2212x1659px: 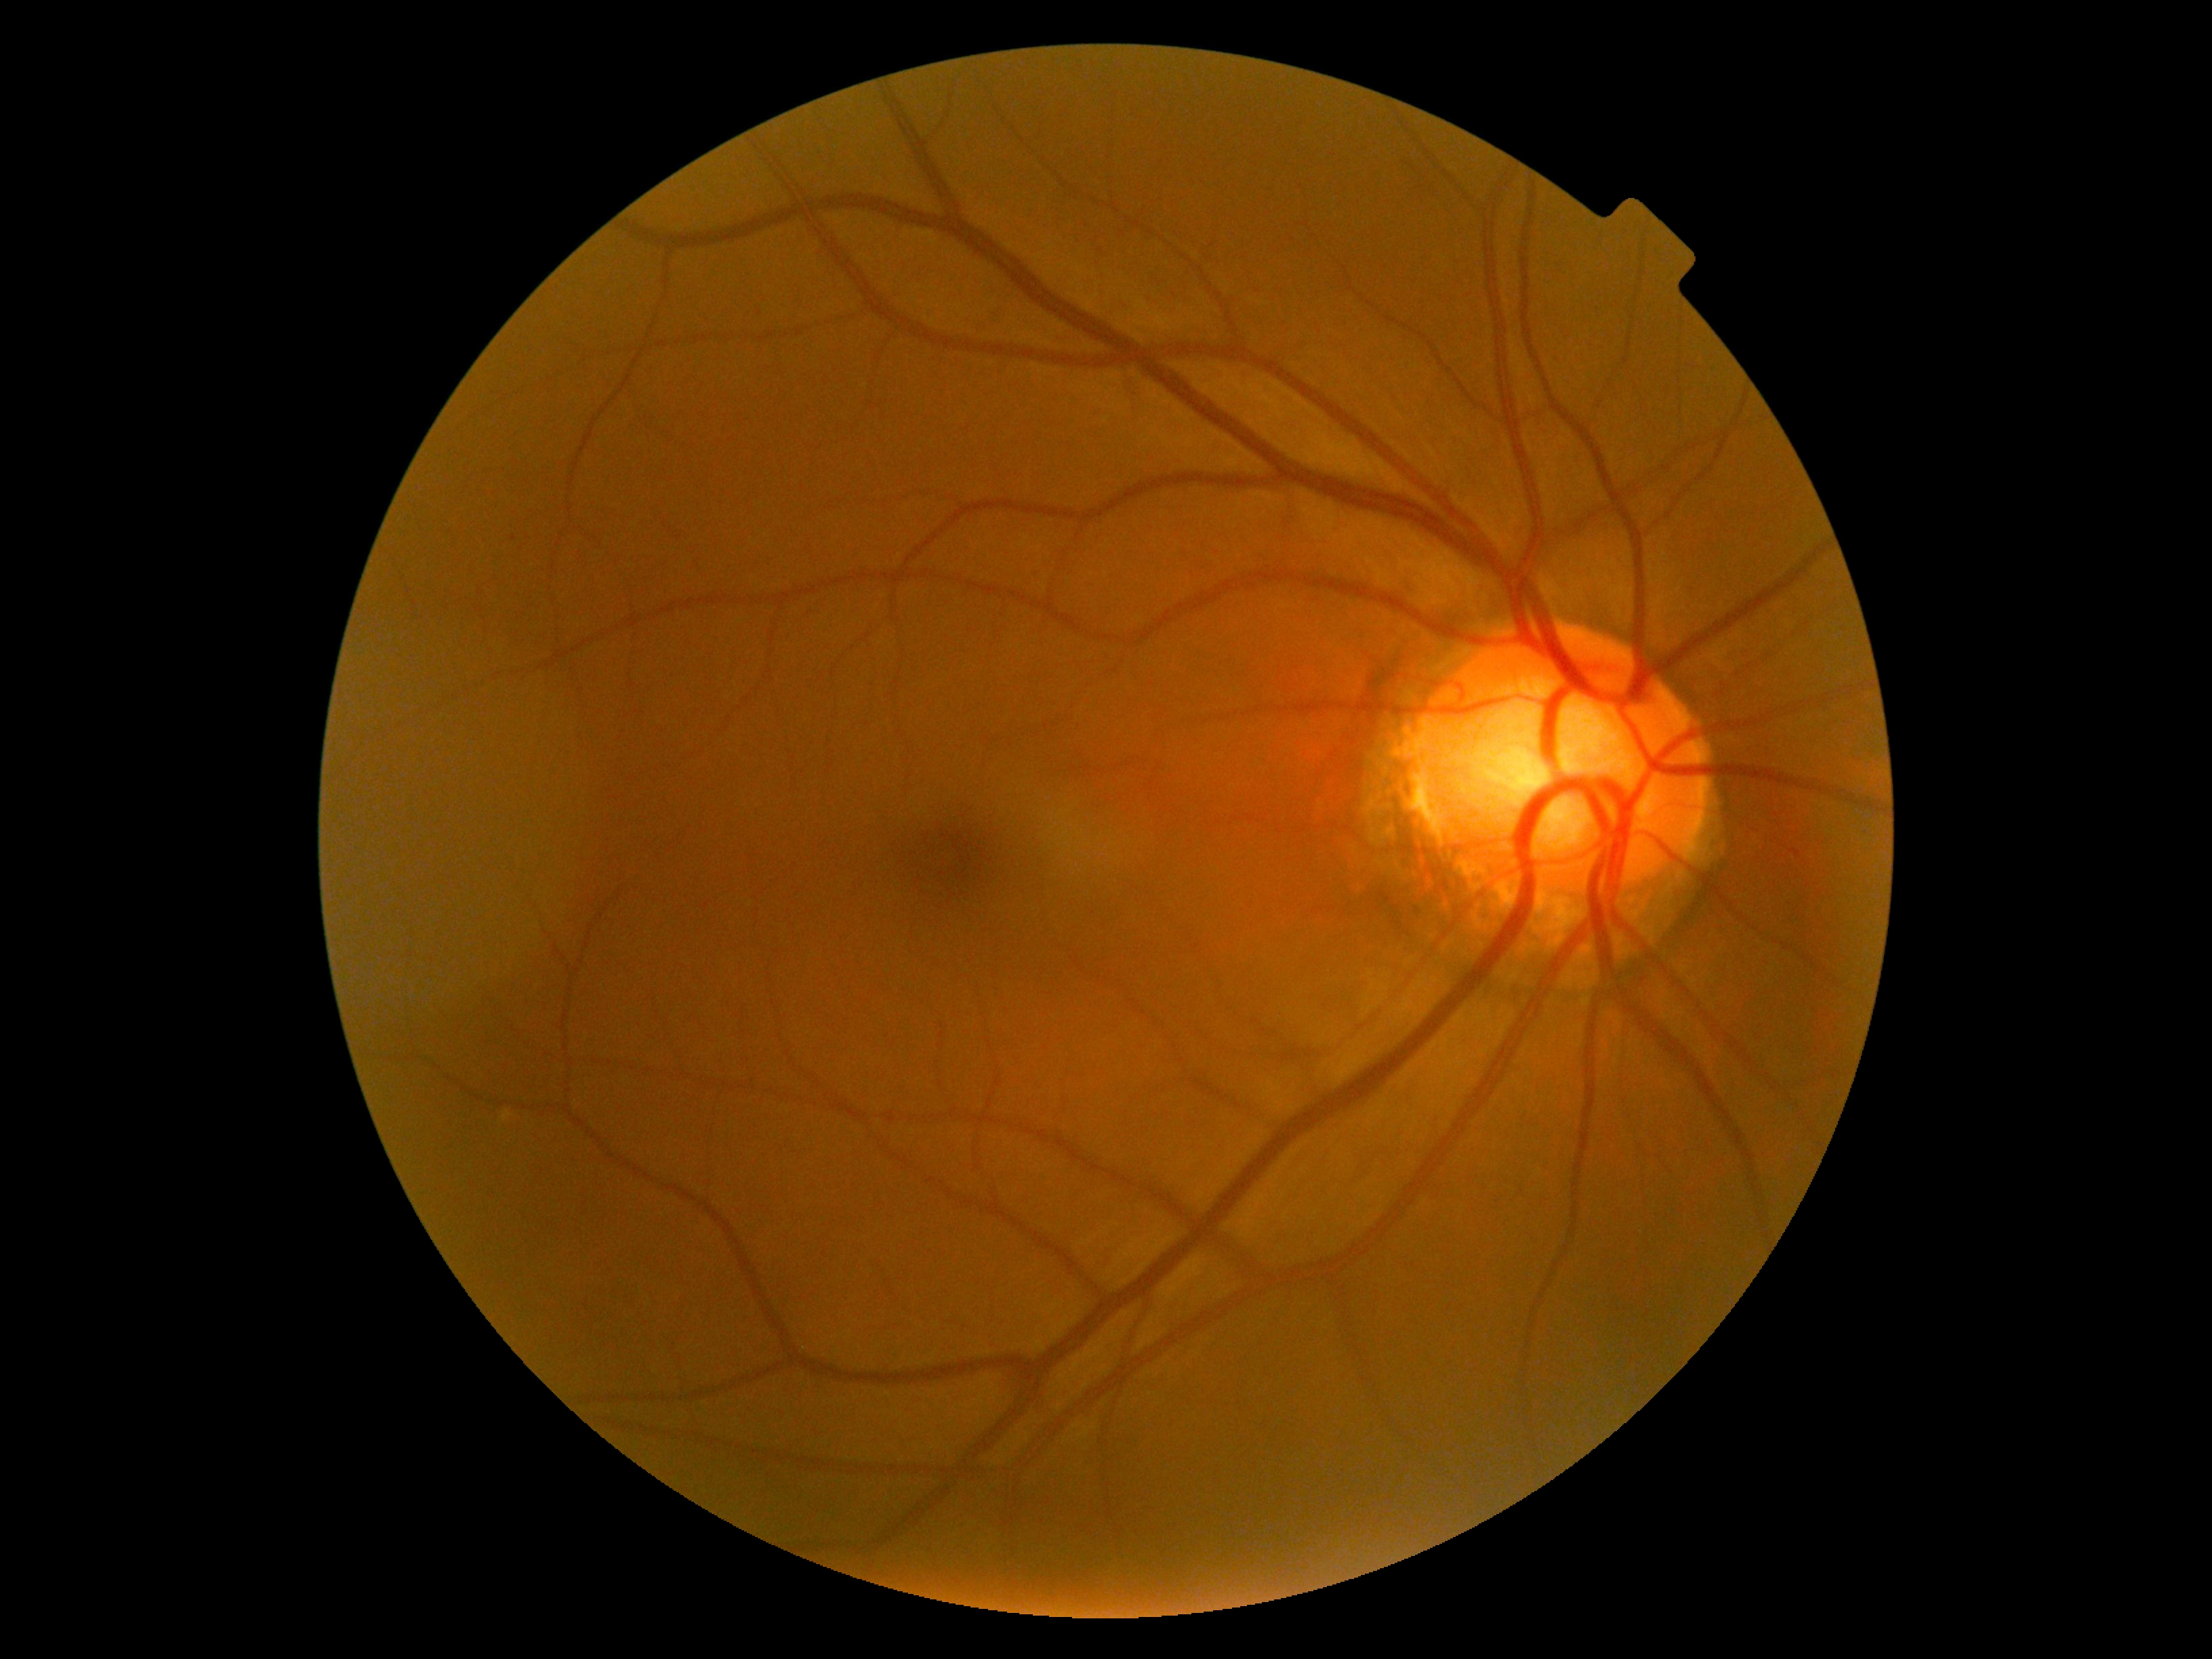

Retinopathy is 0. No diabetic retinal disease findings.